Optic disc region of a color fundus photo: 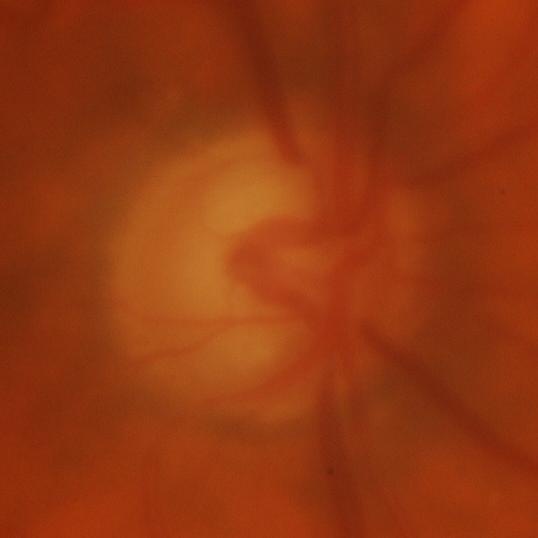
Q: Does this eye have glaucoma?
A: Glaucomatous damage to the optic nerve.